412x310 · fundus photo
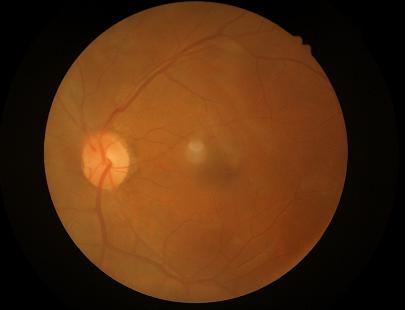 Contrast: narrow intensity range, structures hard to distinguish
Illumination/color: no over- or under-exposure
Focus: clear with no noticeable blur
Overall: poor, ungradable